Color fundus image. NIDEK AFC-230. Nonmydriatic — 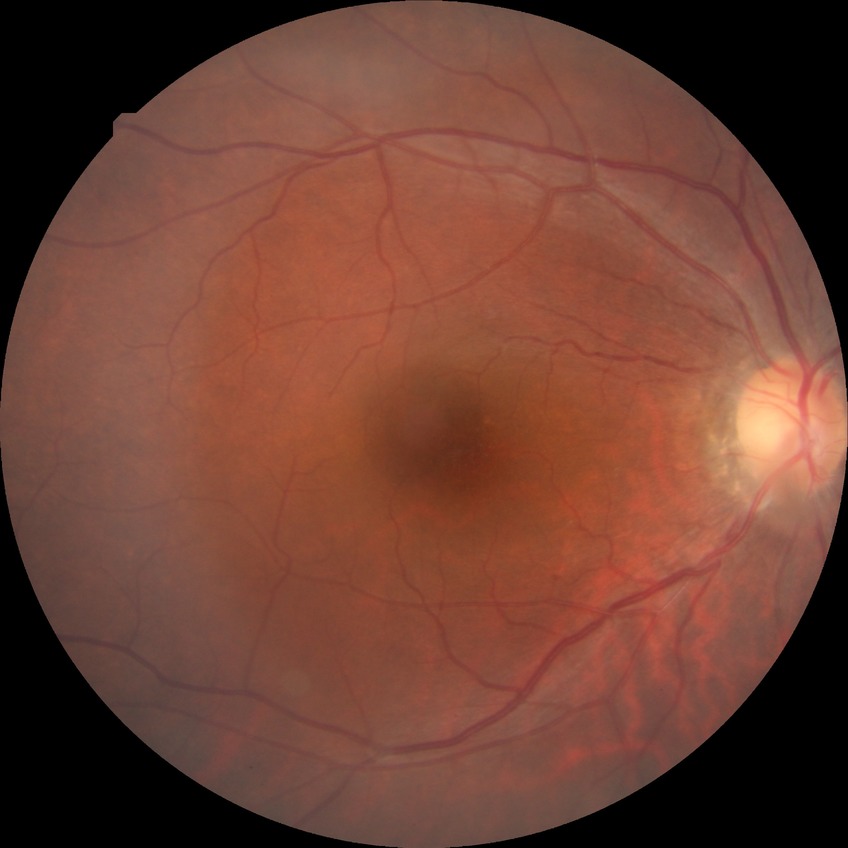

Davis grade: NDR.